848 x 848 pixels · nonmydriatic fundus photograph · Davis DR grading
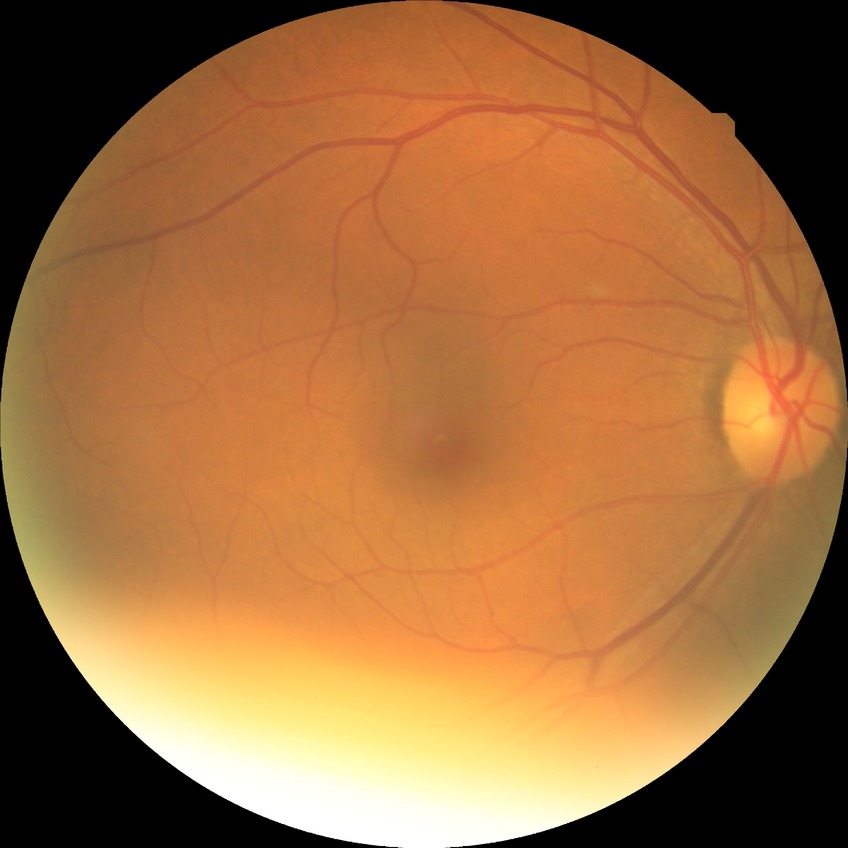

diabetic retinopathy severity: no diabetic retinopathy.